45-degree field of view · image size 2352x1568 · fundus photo — 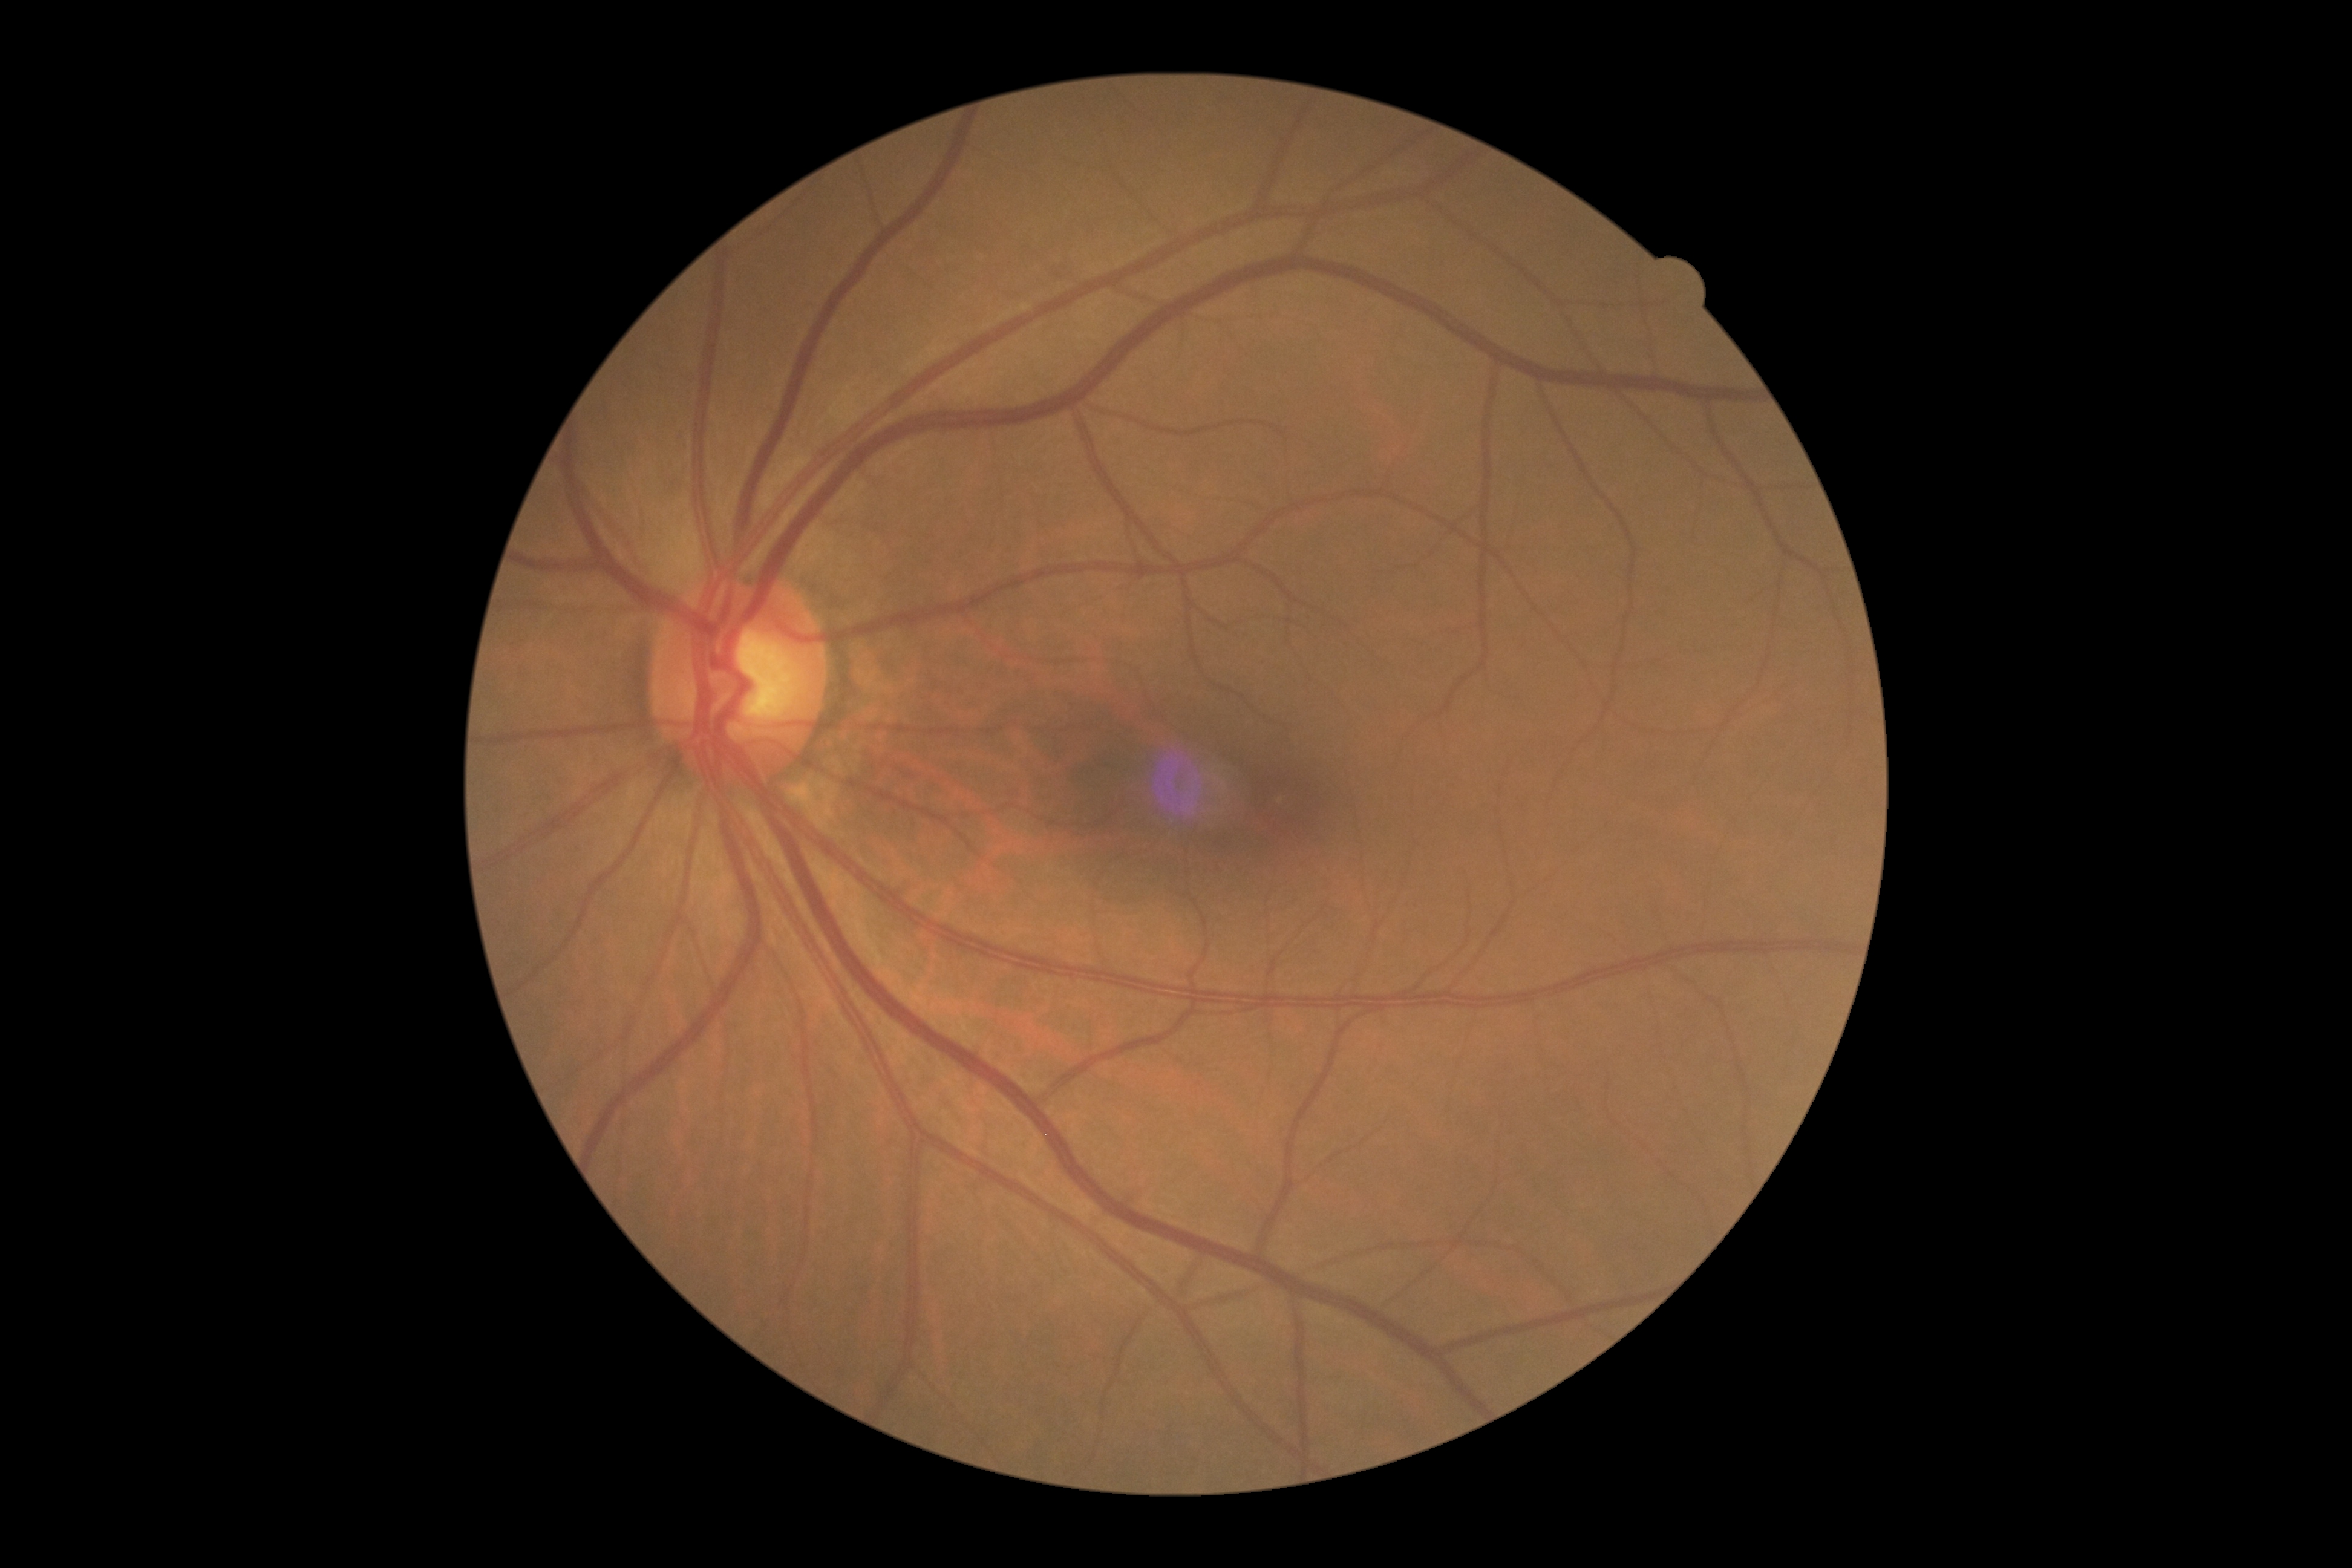
Retinopathy is grade 0 (no apparent retinopathy).